Topcon TRC-NW8, macula-centered
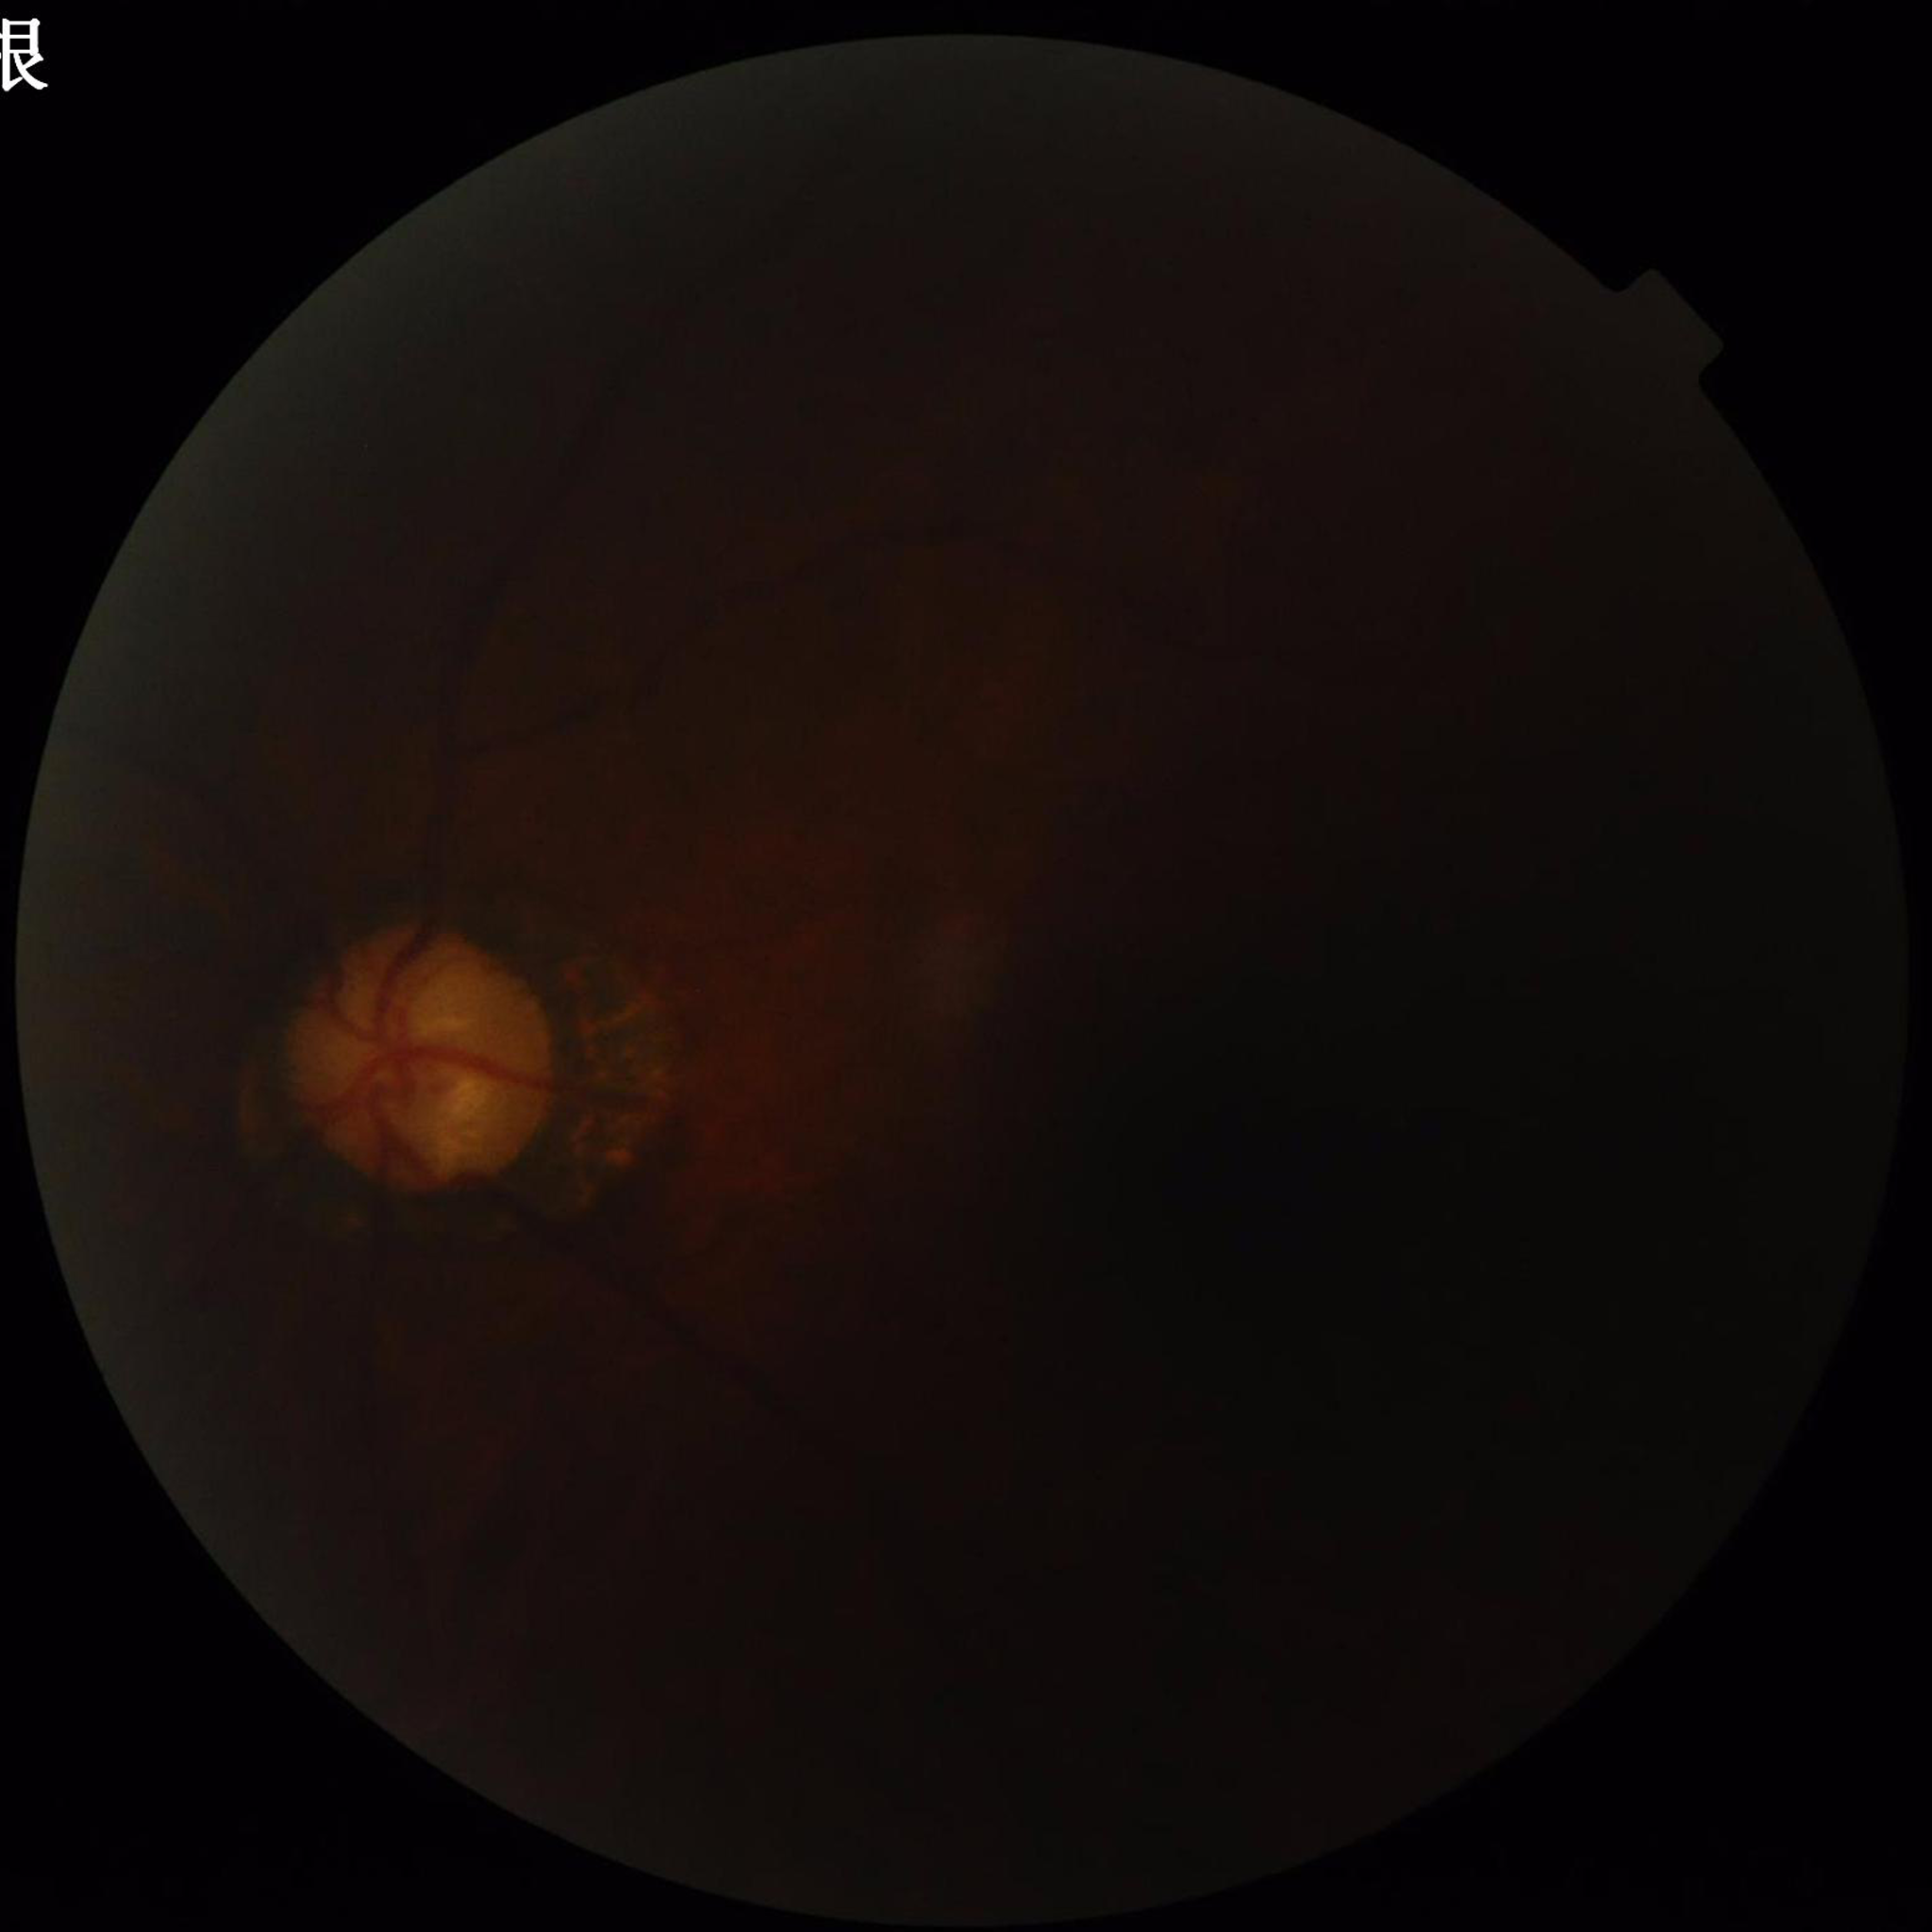

Clinical diagnosis = glaucoma | Photo quality = issues noted — blur, low contrast, illumination/color distortion.